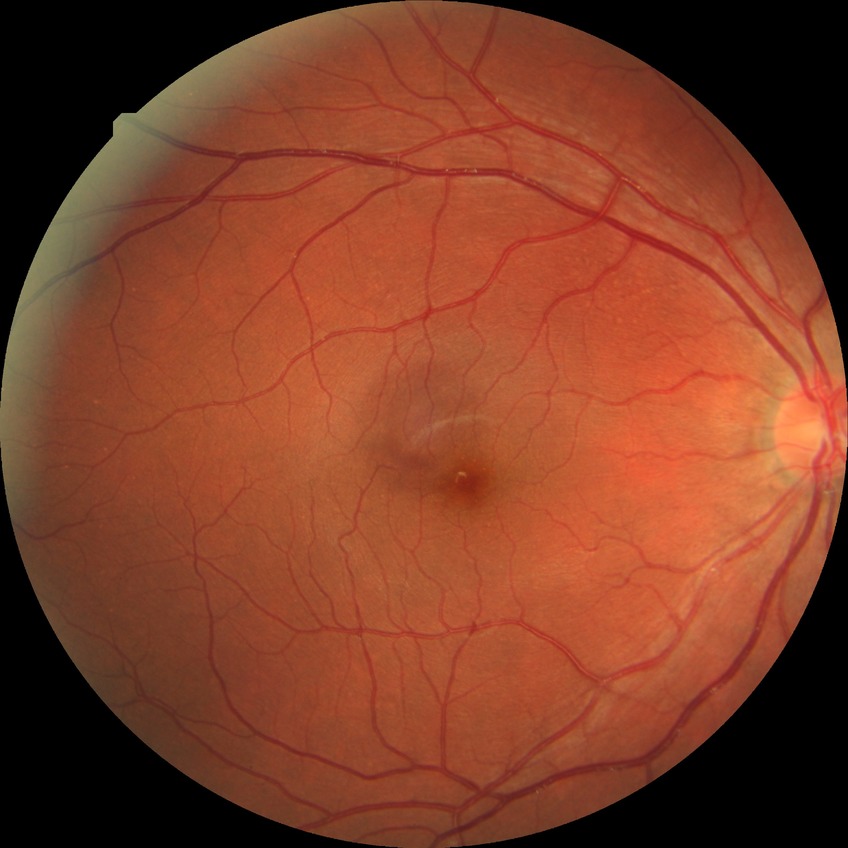
Diabetic retinopathy (DR) is NDR (no diabetic retinopathy).